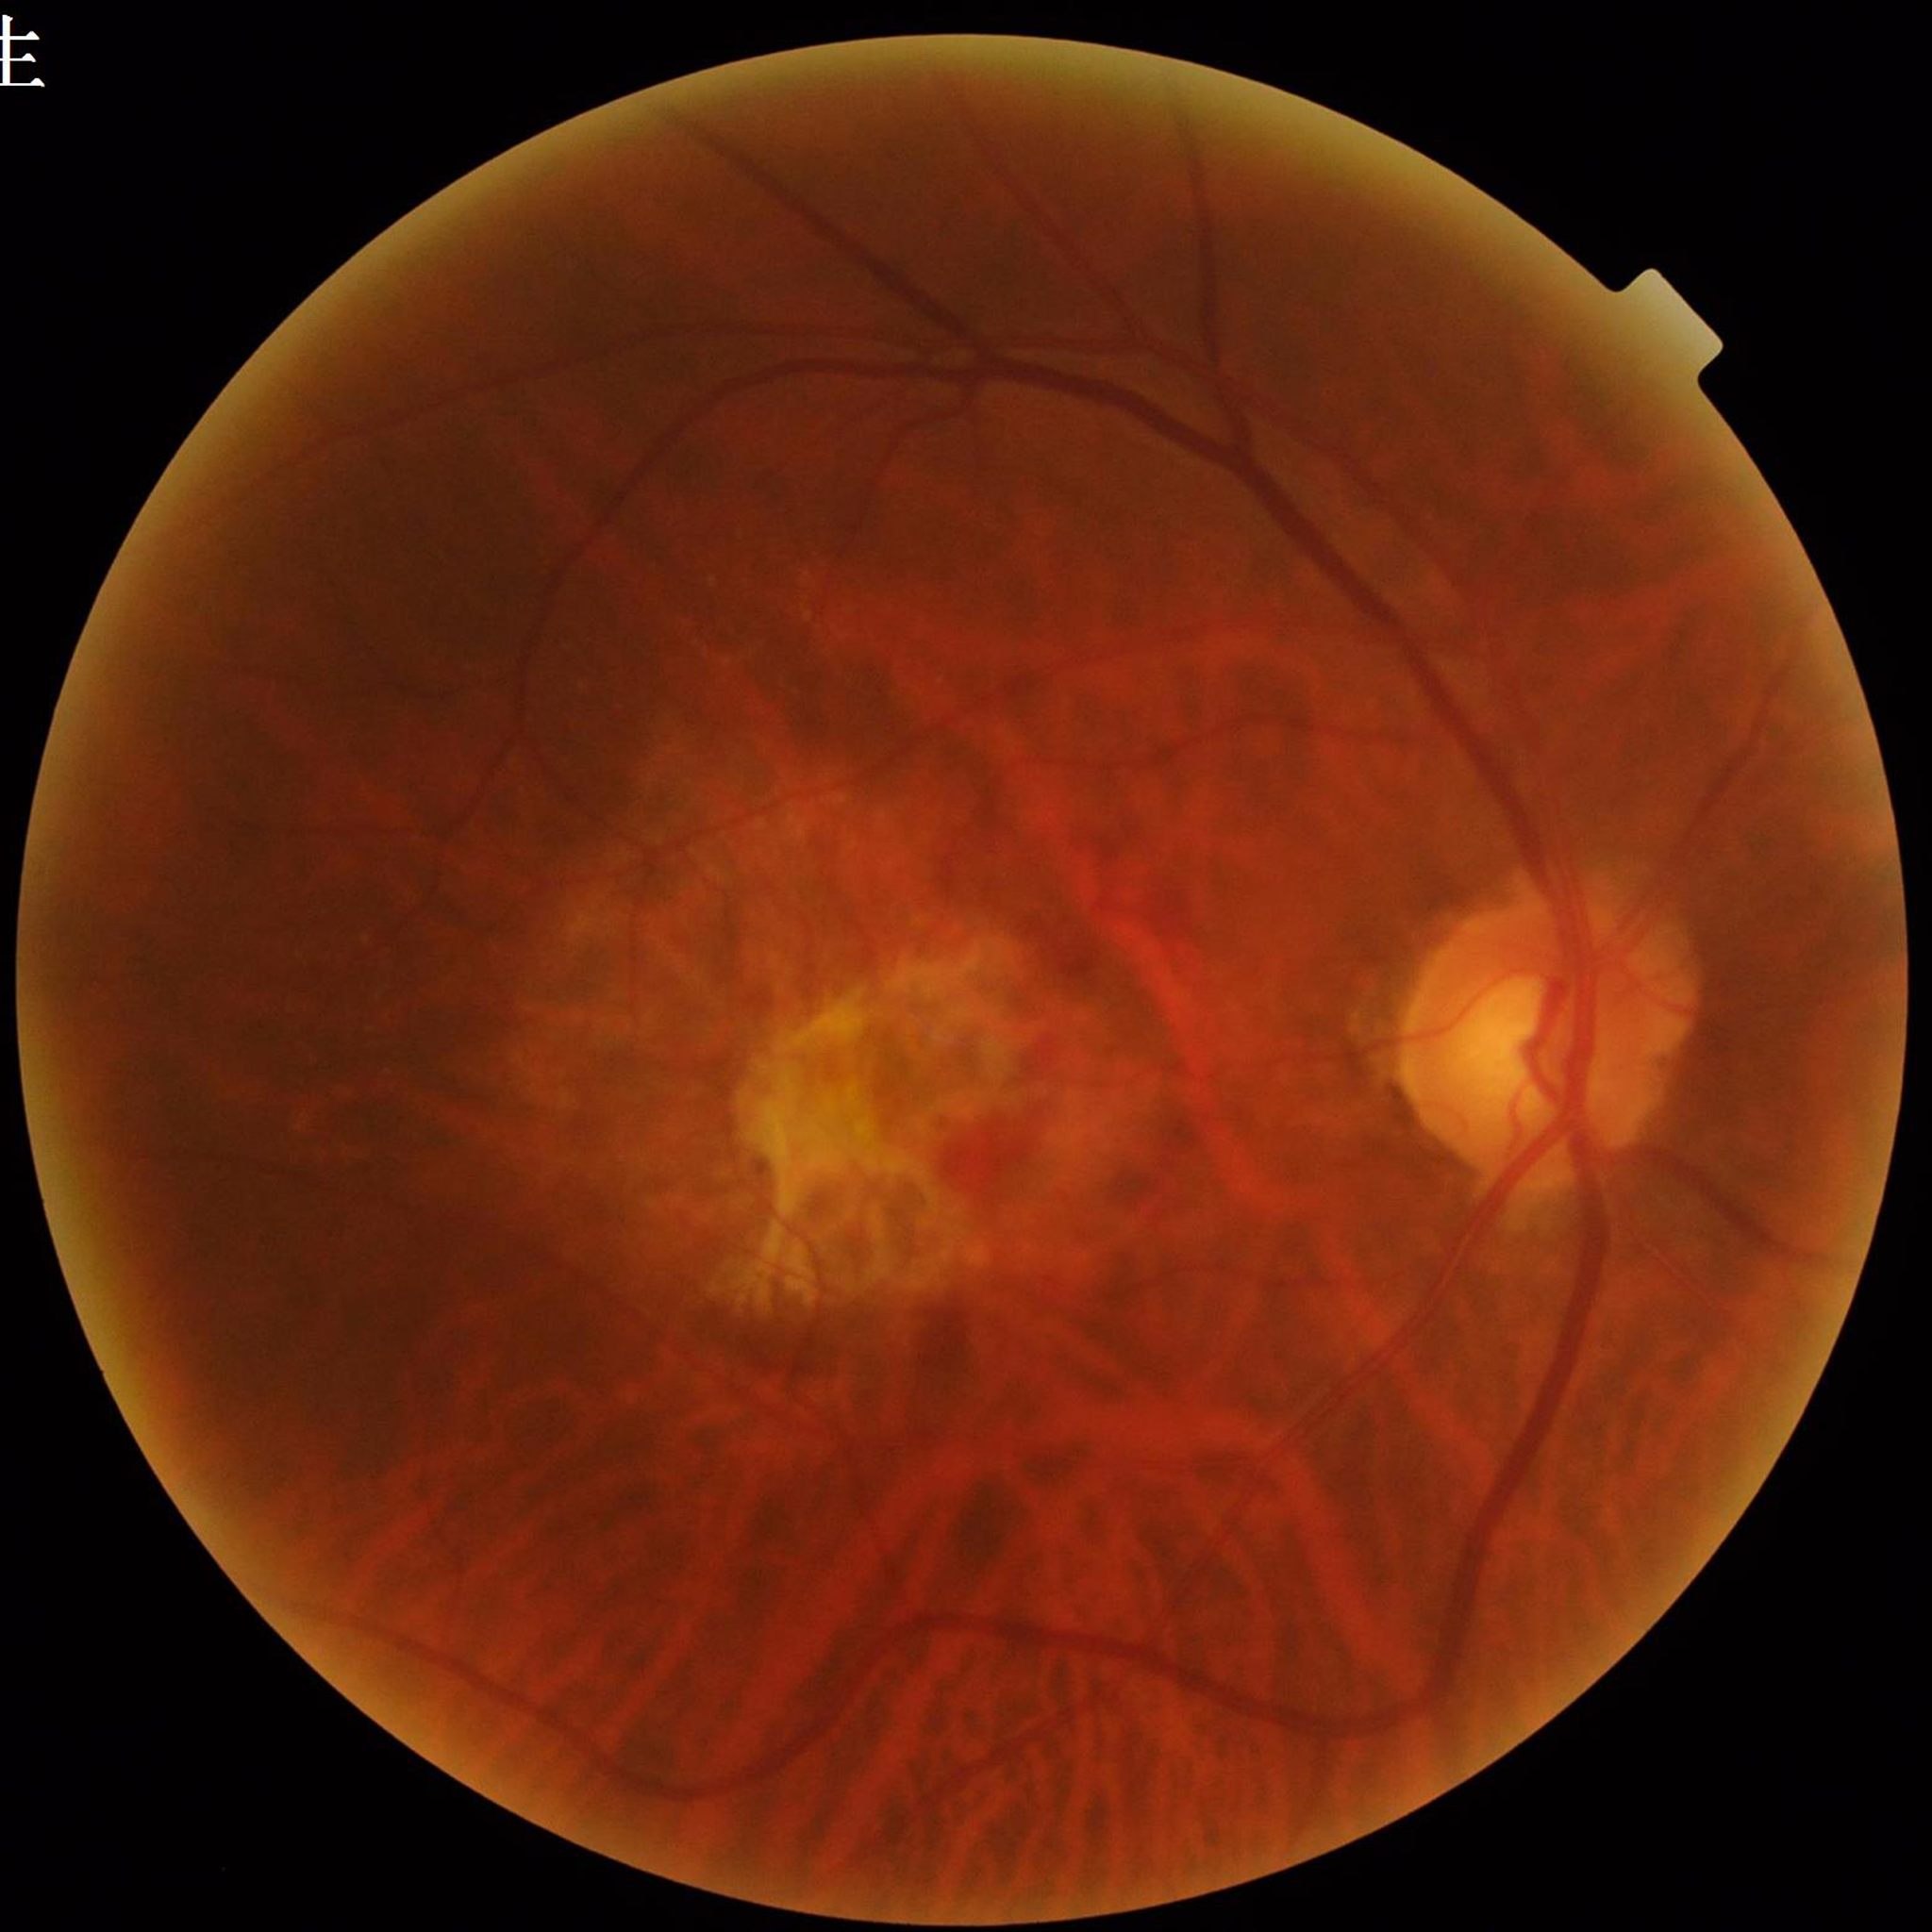 Retinal fundus photograph from a patient with age-related macular degeneration (AMD). Quality: good.